2352 by 1568 pixels · FOV: 45 degrees · color fundus photograph — 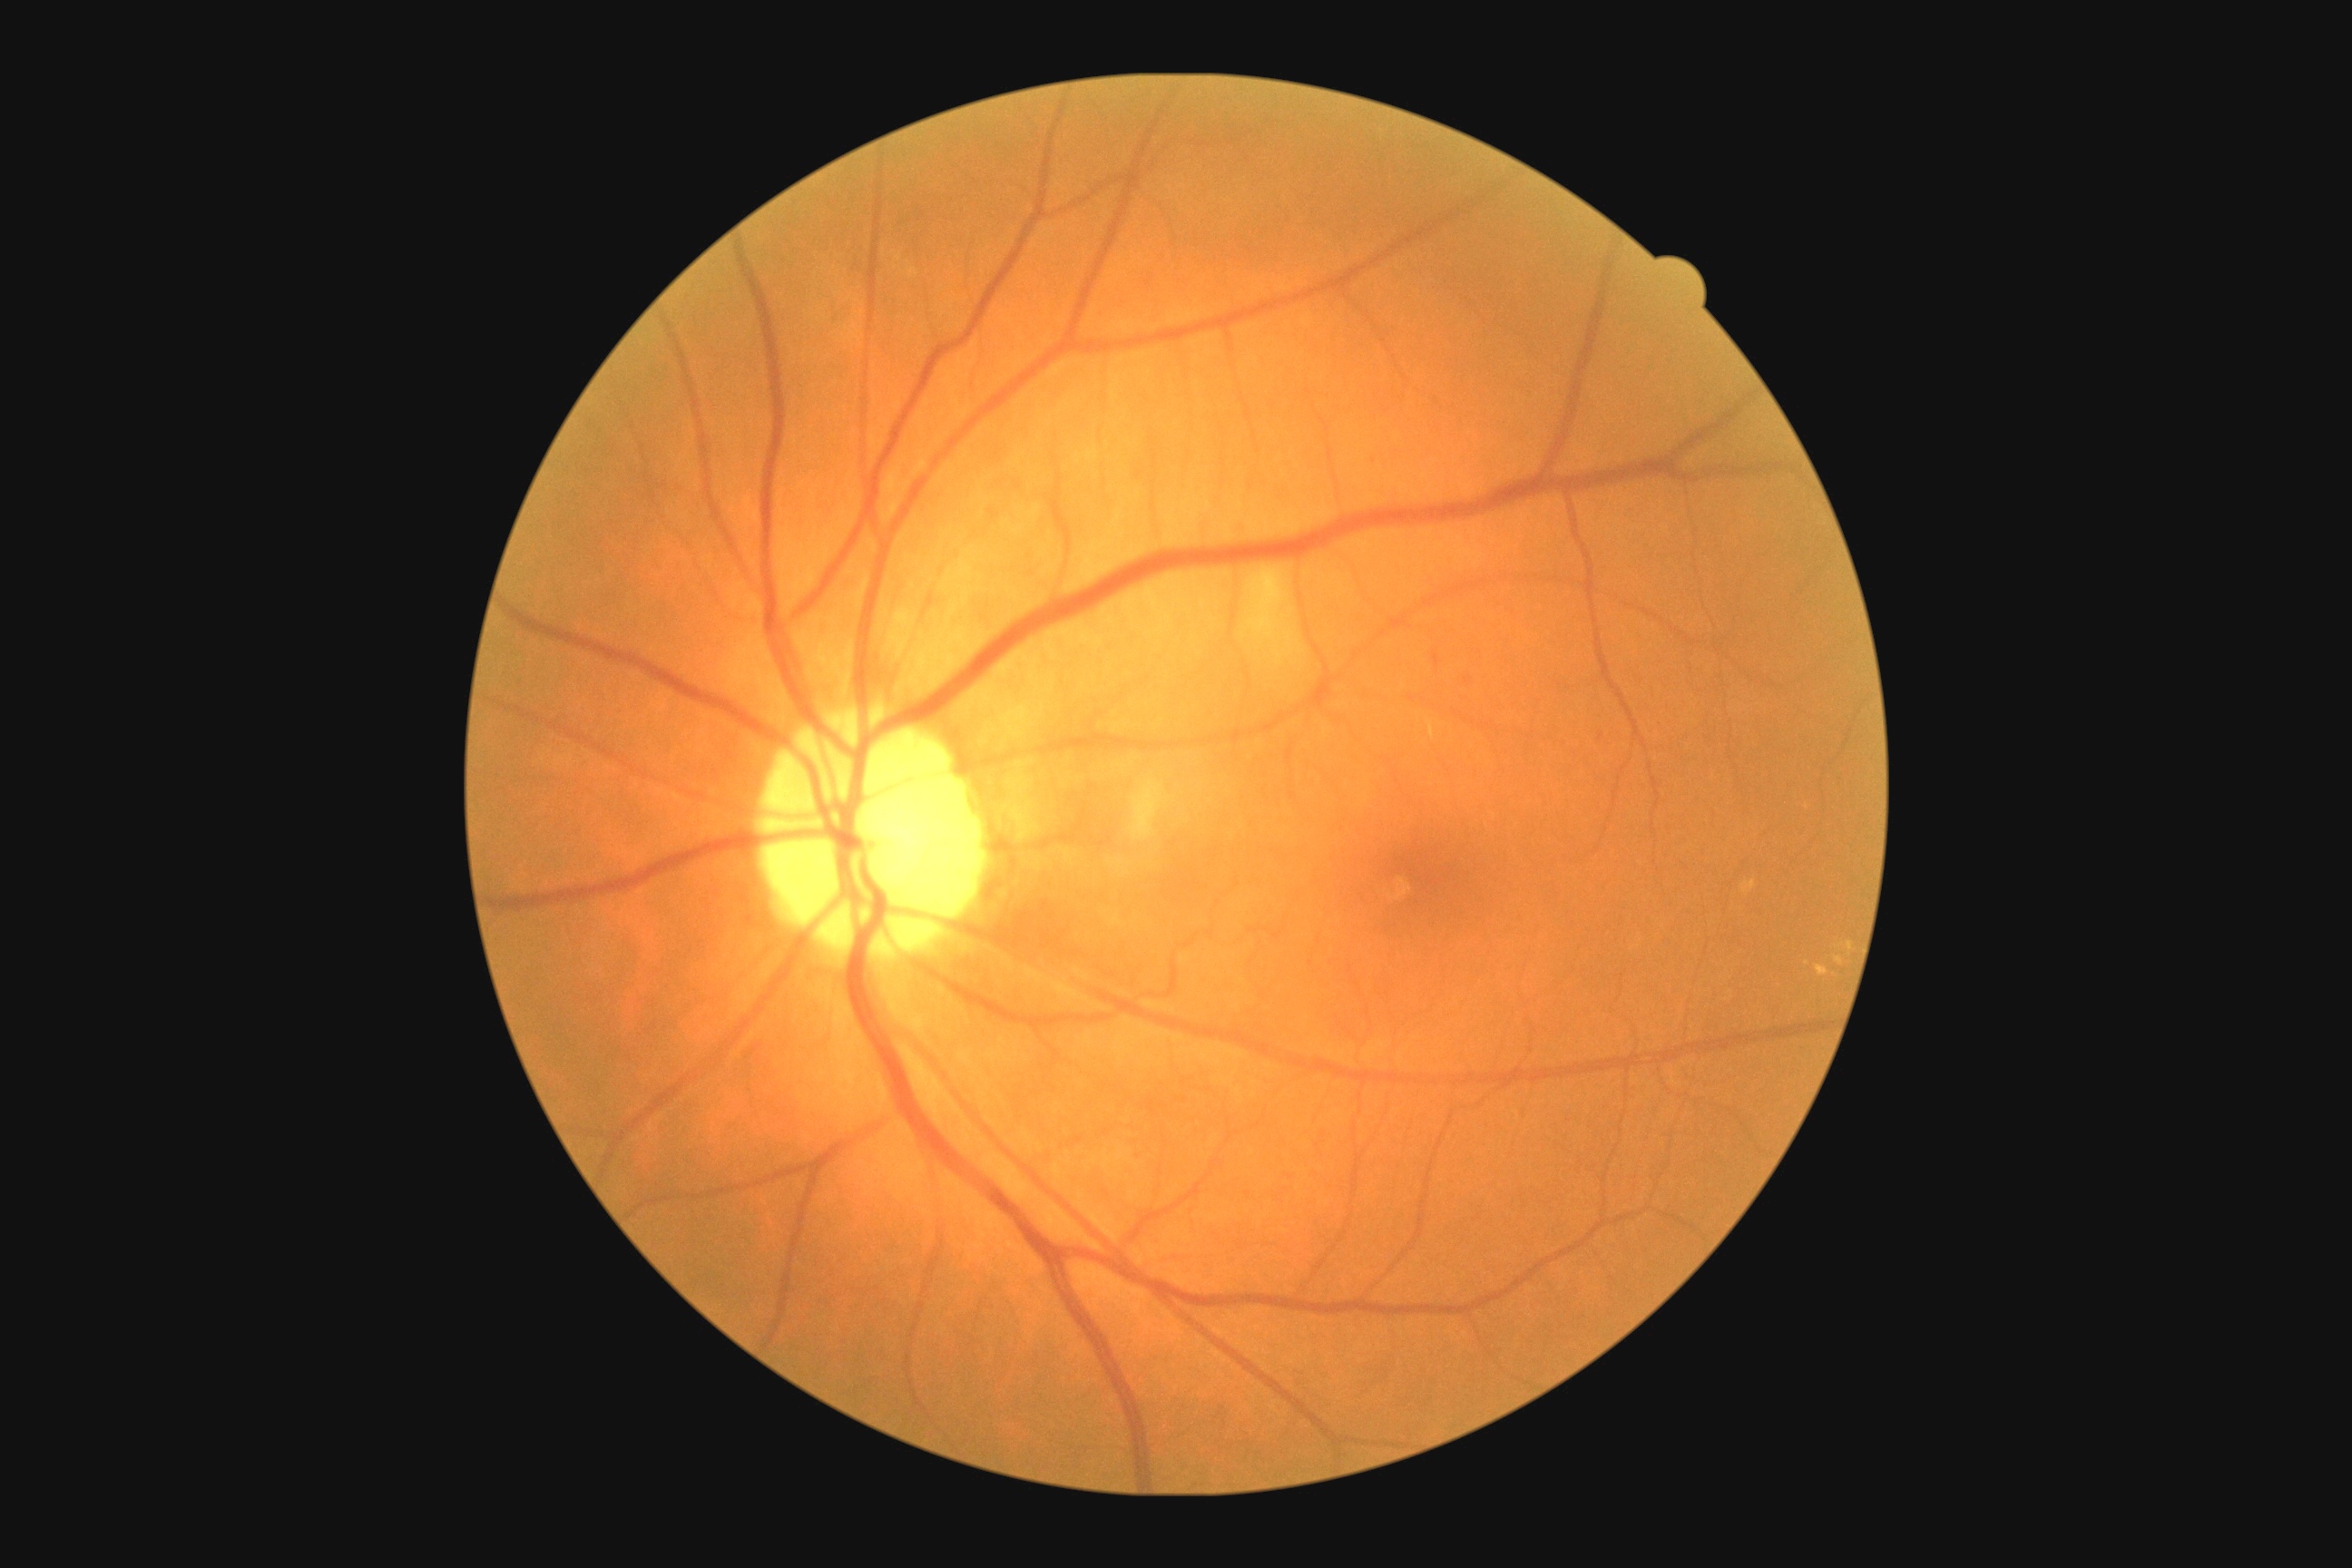

retinopathy@grade 2.